Image size 1932x1923 · CFP.
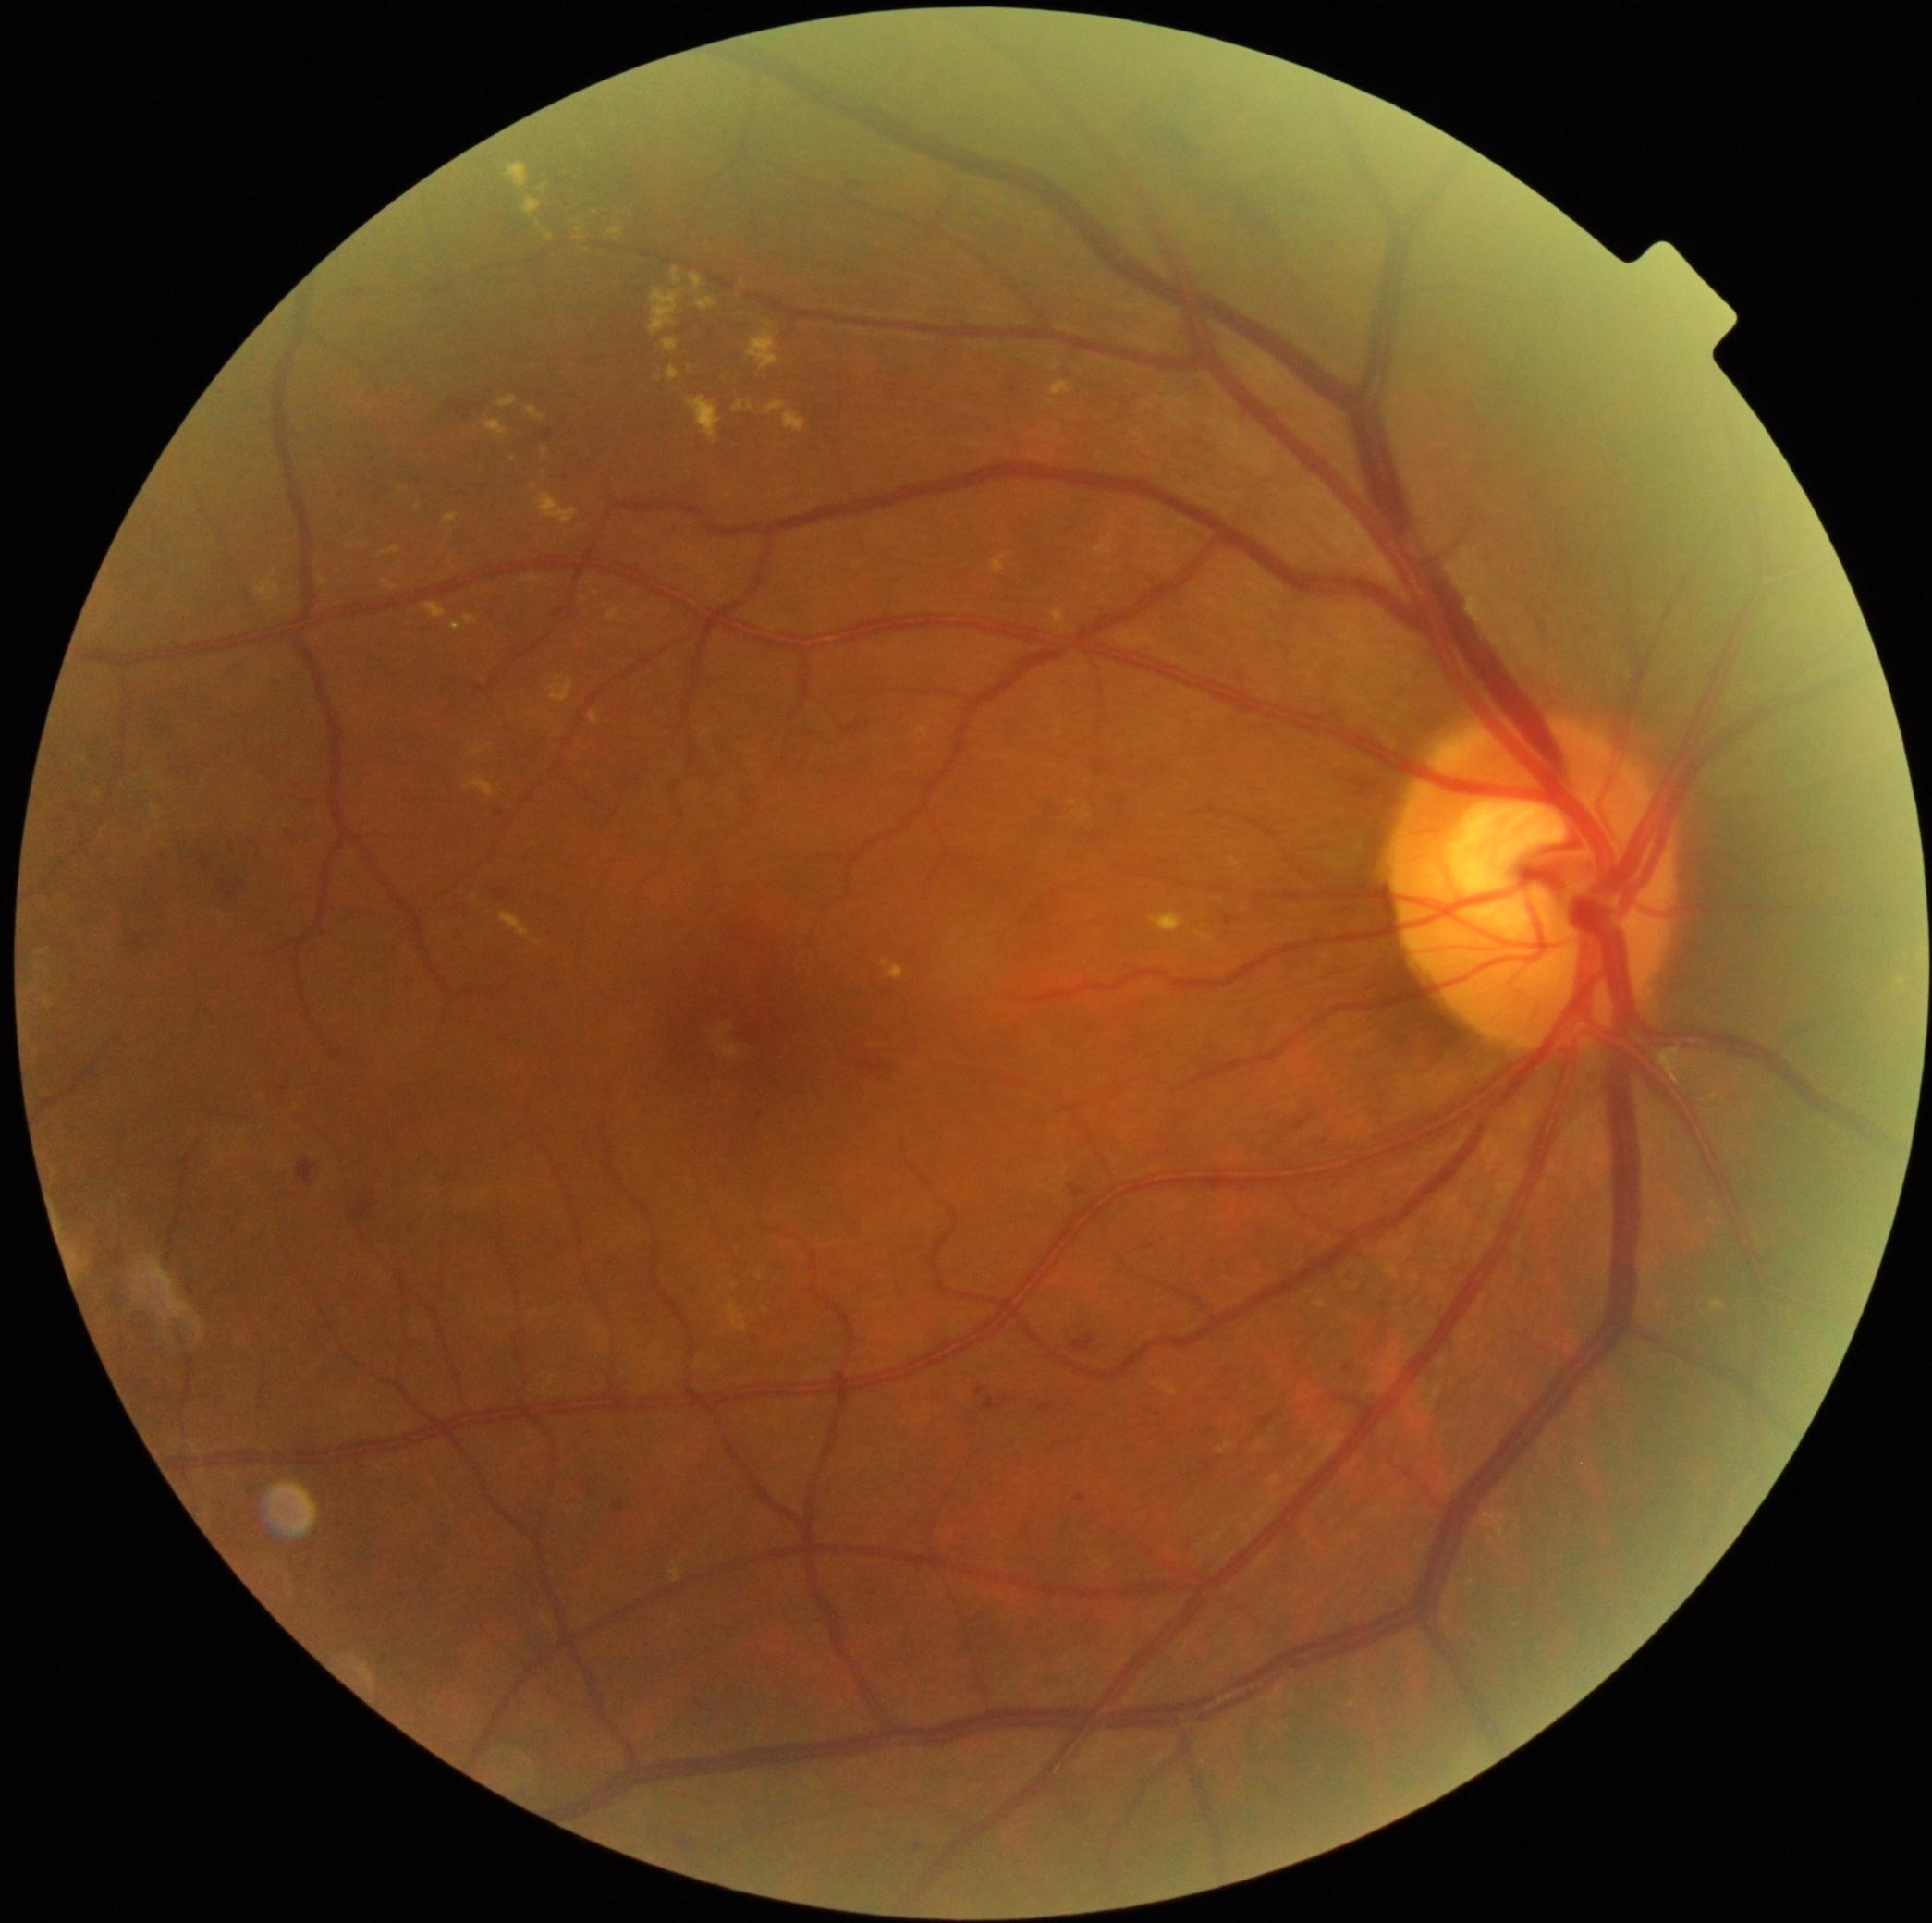

{"partial": true, "dr_grade": 2, "dr_grade_name": "moderate NPDR", "lesions": {"ex": [[607, 609, 620, 622], [534, 493, 579, 525], [414, 505, 422, 512], [1053, 383, 1071, 398], [1051, 609, 1068, 630], [667, 366, 680, 383], [485, 422, 509, 439], [669, 1563, 680, 1585], [714, 589, 723, 598], [348, 545, 356, 549], [257, 579, 281, 604], [1230, 858, 1241, 869]], "ex_small_approx": [[833, 641], [534, 488], [552, 717], [881, 655], [630, 215]]}}